Image size 2352x1568:
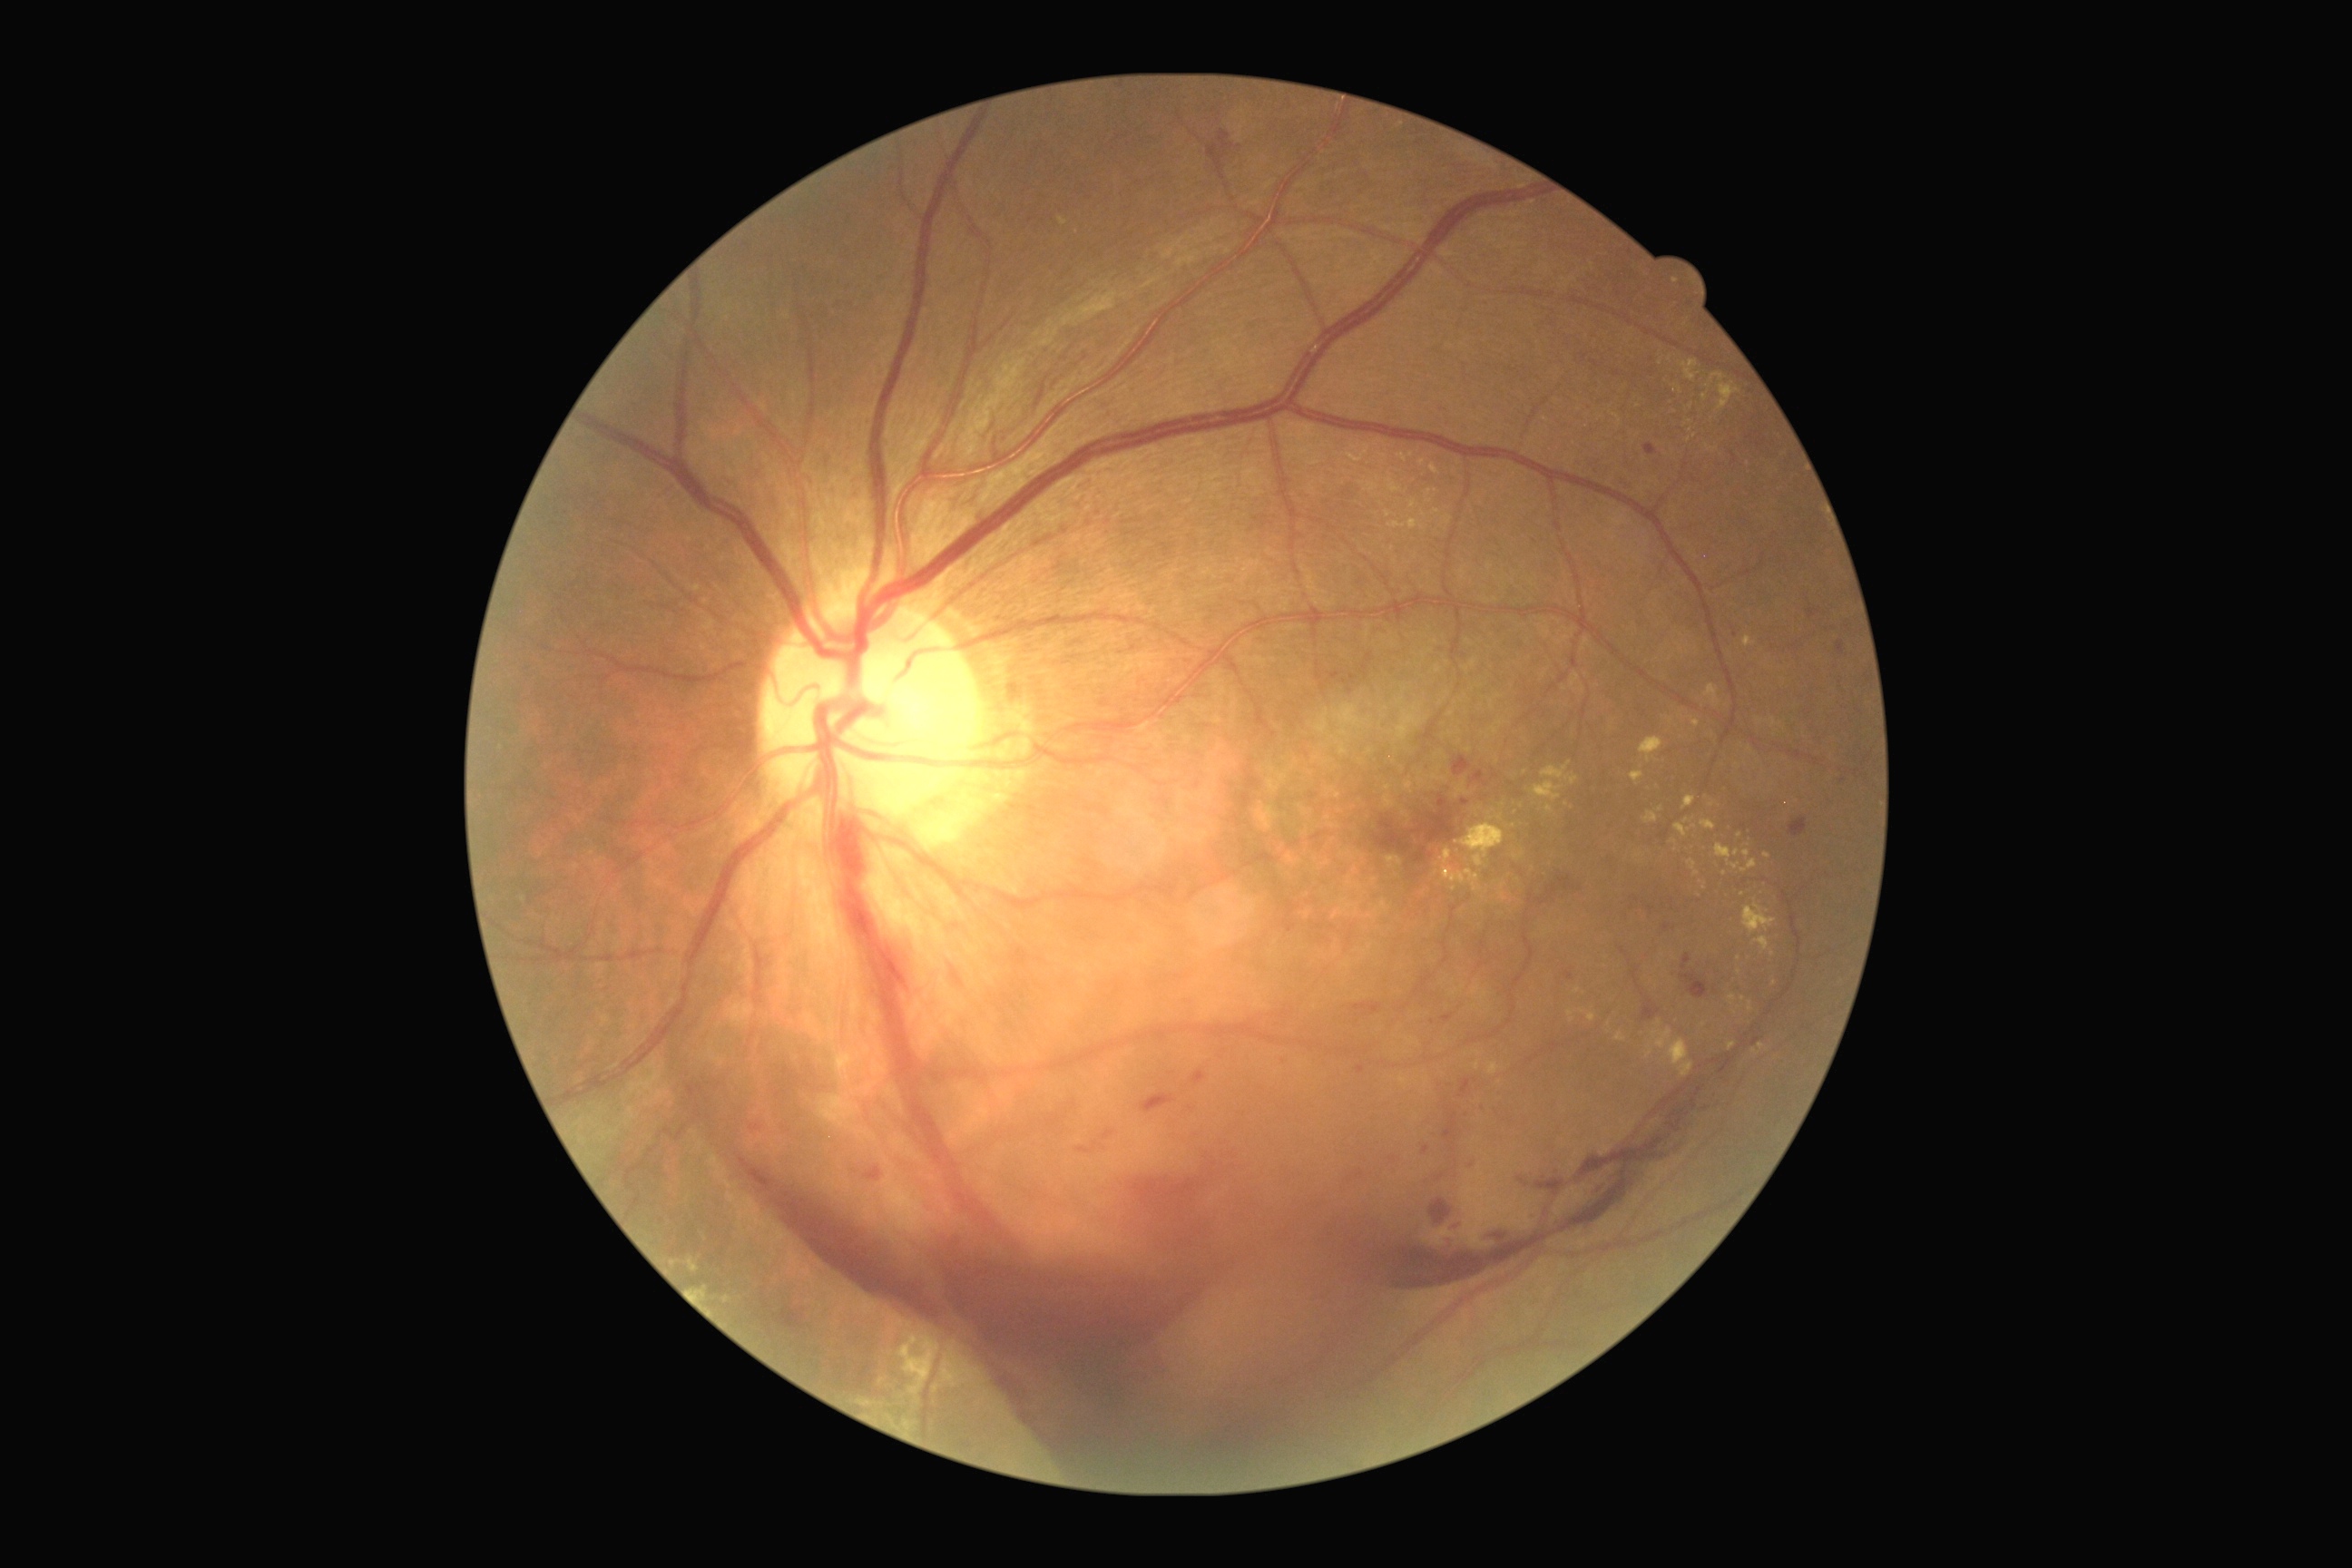

Retinopathy is 4/4. Disease class: proliferative diabetic retinopathy.